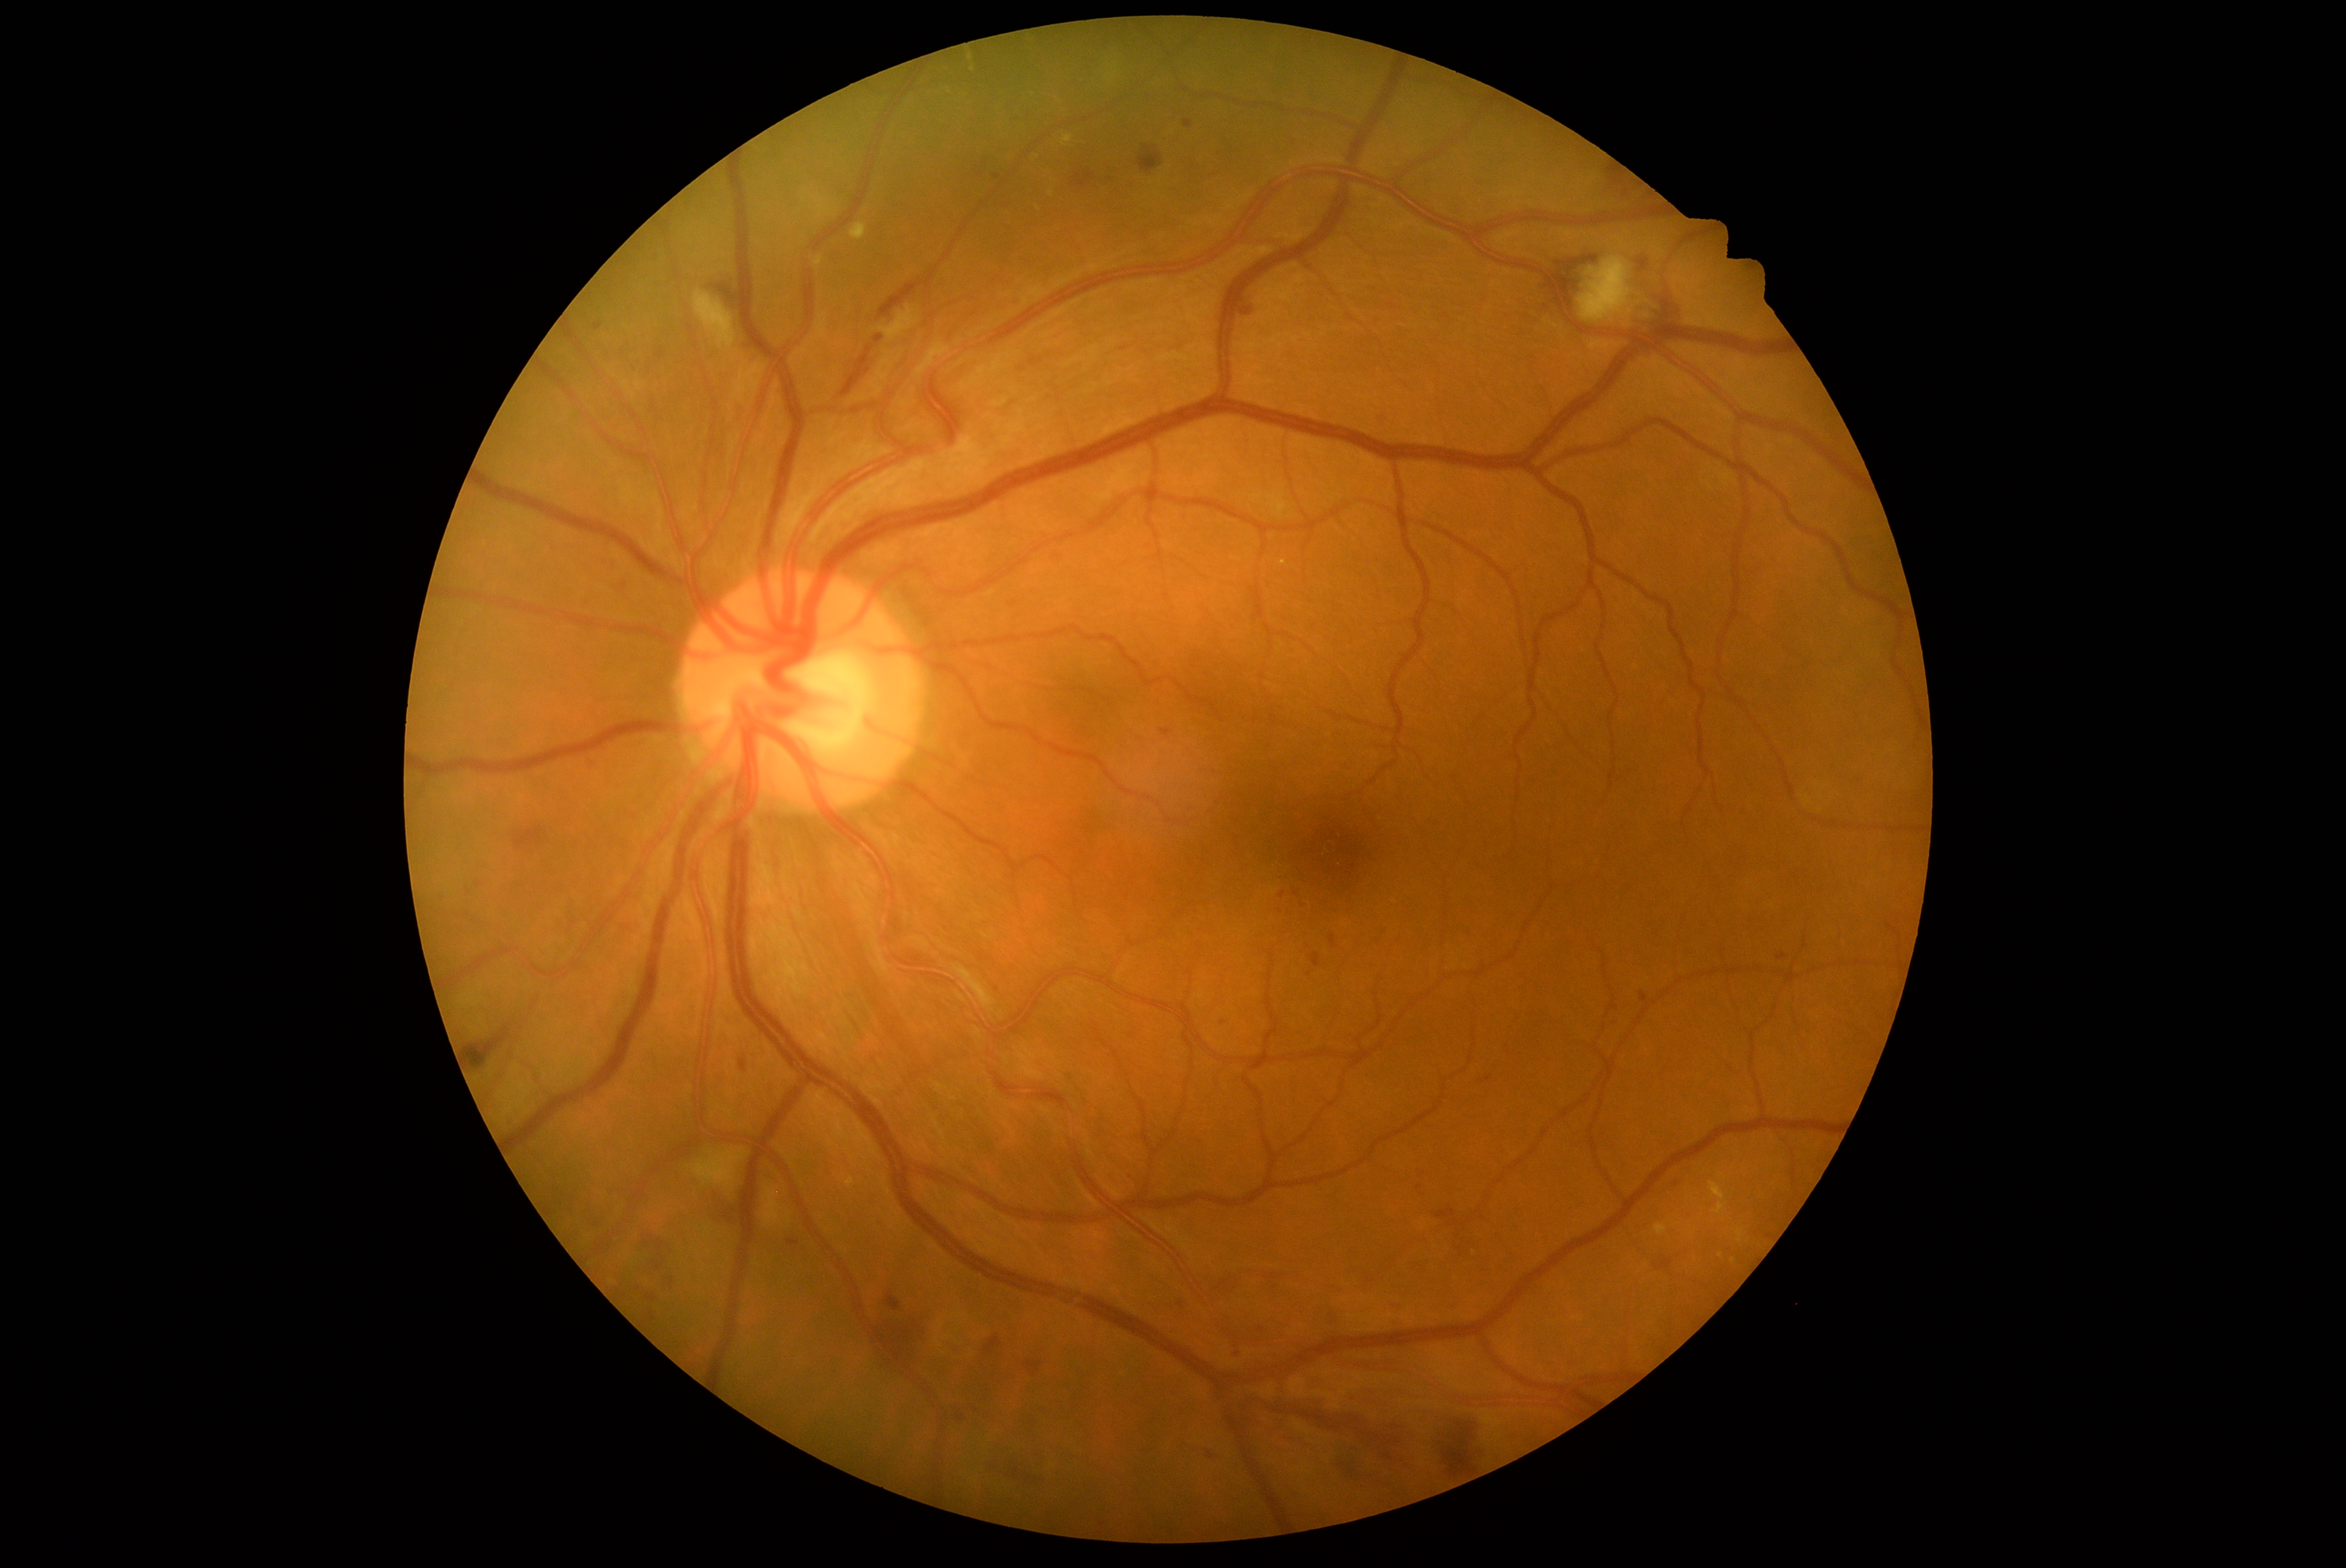 Diabetic retinopathy (DR): grade 2
Lesions identified (partial list):
microaneurysms (MAs) (more not shown): {"left": 1183, "top": 120, "right": 1194, "bottom": 129}; {"left": 788, "top": 1240, "right": 801, "bottom": 1246}; {"left": 1233, "top": 1351, "right": 1241, "bottom": 1359}; {"left": 1610, "top": 1006, "right": 1618, "bottom": 1011}; {"left": 1378, "top": 416, "right": 1387, "bottom": 424}; {"left": 1224, "top": 1018, "right": 1230, "bottom": 1026}
MAs (small, approximate centers) near [x=1613, y=1026]; [x=1131, y=1174]; [x=1282, y=896]; [x=1261, y=1330]; [x=1419, y=1186]
hemorrhages (HEs) (more not shown): {"left": 666, "top": 1279, "right": 672, "bottom": 1299}; {"left": 1636, "top": 258, "right": 1651, "bottom": 270}; {"left": 1447, "top": 1301, "right": 1462, "bottom": 1305}; {"left": 1331, "top": 935, "right": 1335, "bottom": 946}; {"left": 1444, "top": 1410, "right": 1481, "bottom": 1475}; {"left": 1555, "top": 255, "right": 1599, "bottom": 318}; {"left": 1337, "top": 1446, "right": 1365, "bottom": 1486}; {"left": 710, "top": 283, "right": 739, "bottom": 307}; {"left": 885, "top": 1296, "right": 902, "bottom": 1312}; {"left": 645, "top": 1296, "right": 659, "bottom": 1302}; {"left": 515, "top": 827, "right": 543, "bottom": 848}; {"left": 1199, "top": 1451, "right": 1219, "bottom": 1459}; {"left": 984, "top": 1337, "right": 1003, "bottom": 1356}; {"left": 711, "top": 1192, "right": 736, "bottom": 1224}; {"left": 840, "top": 347, "right": 873, "bottom": 397}